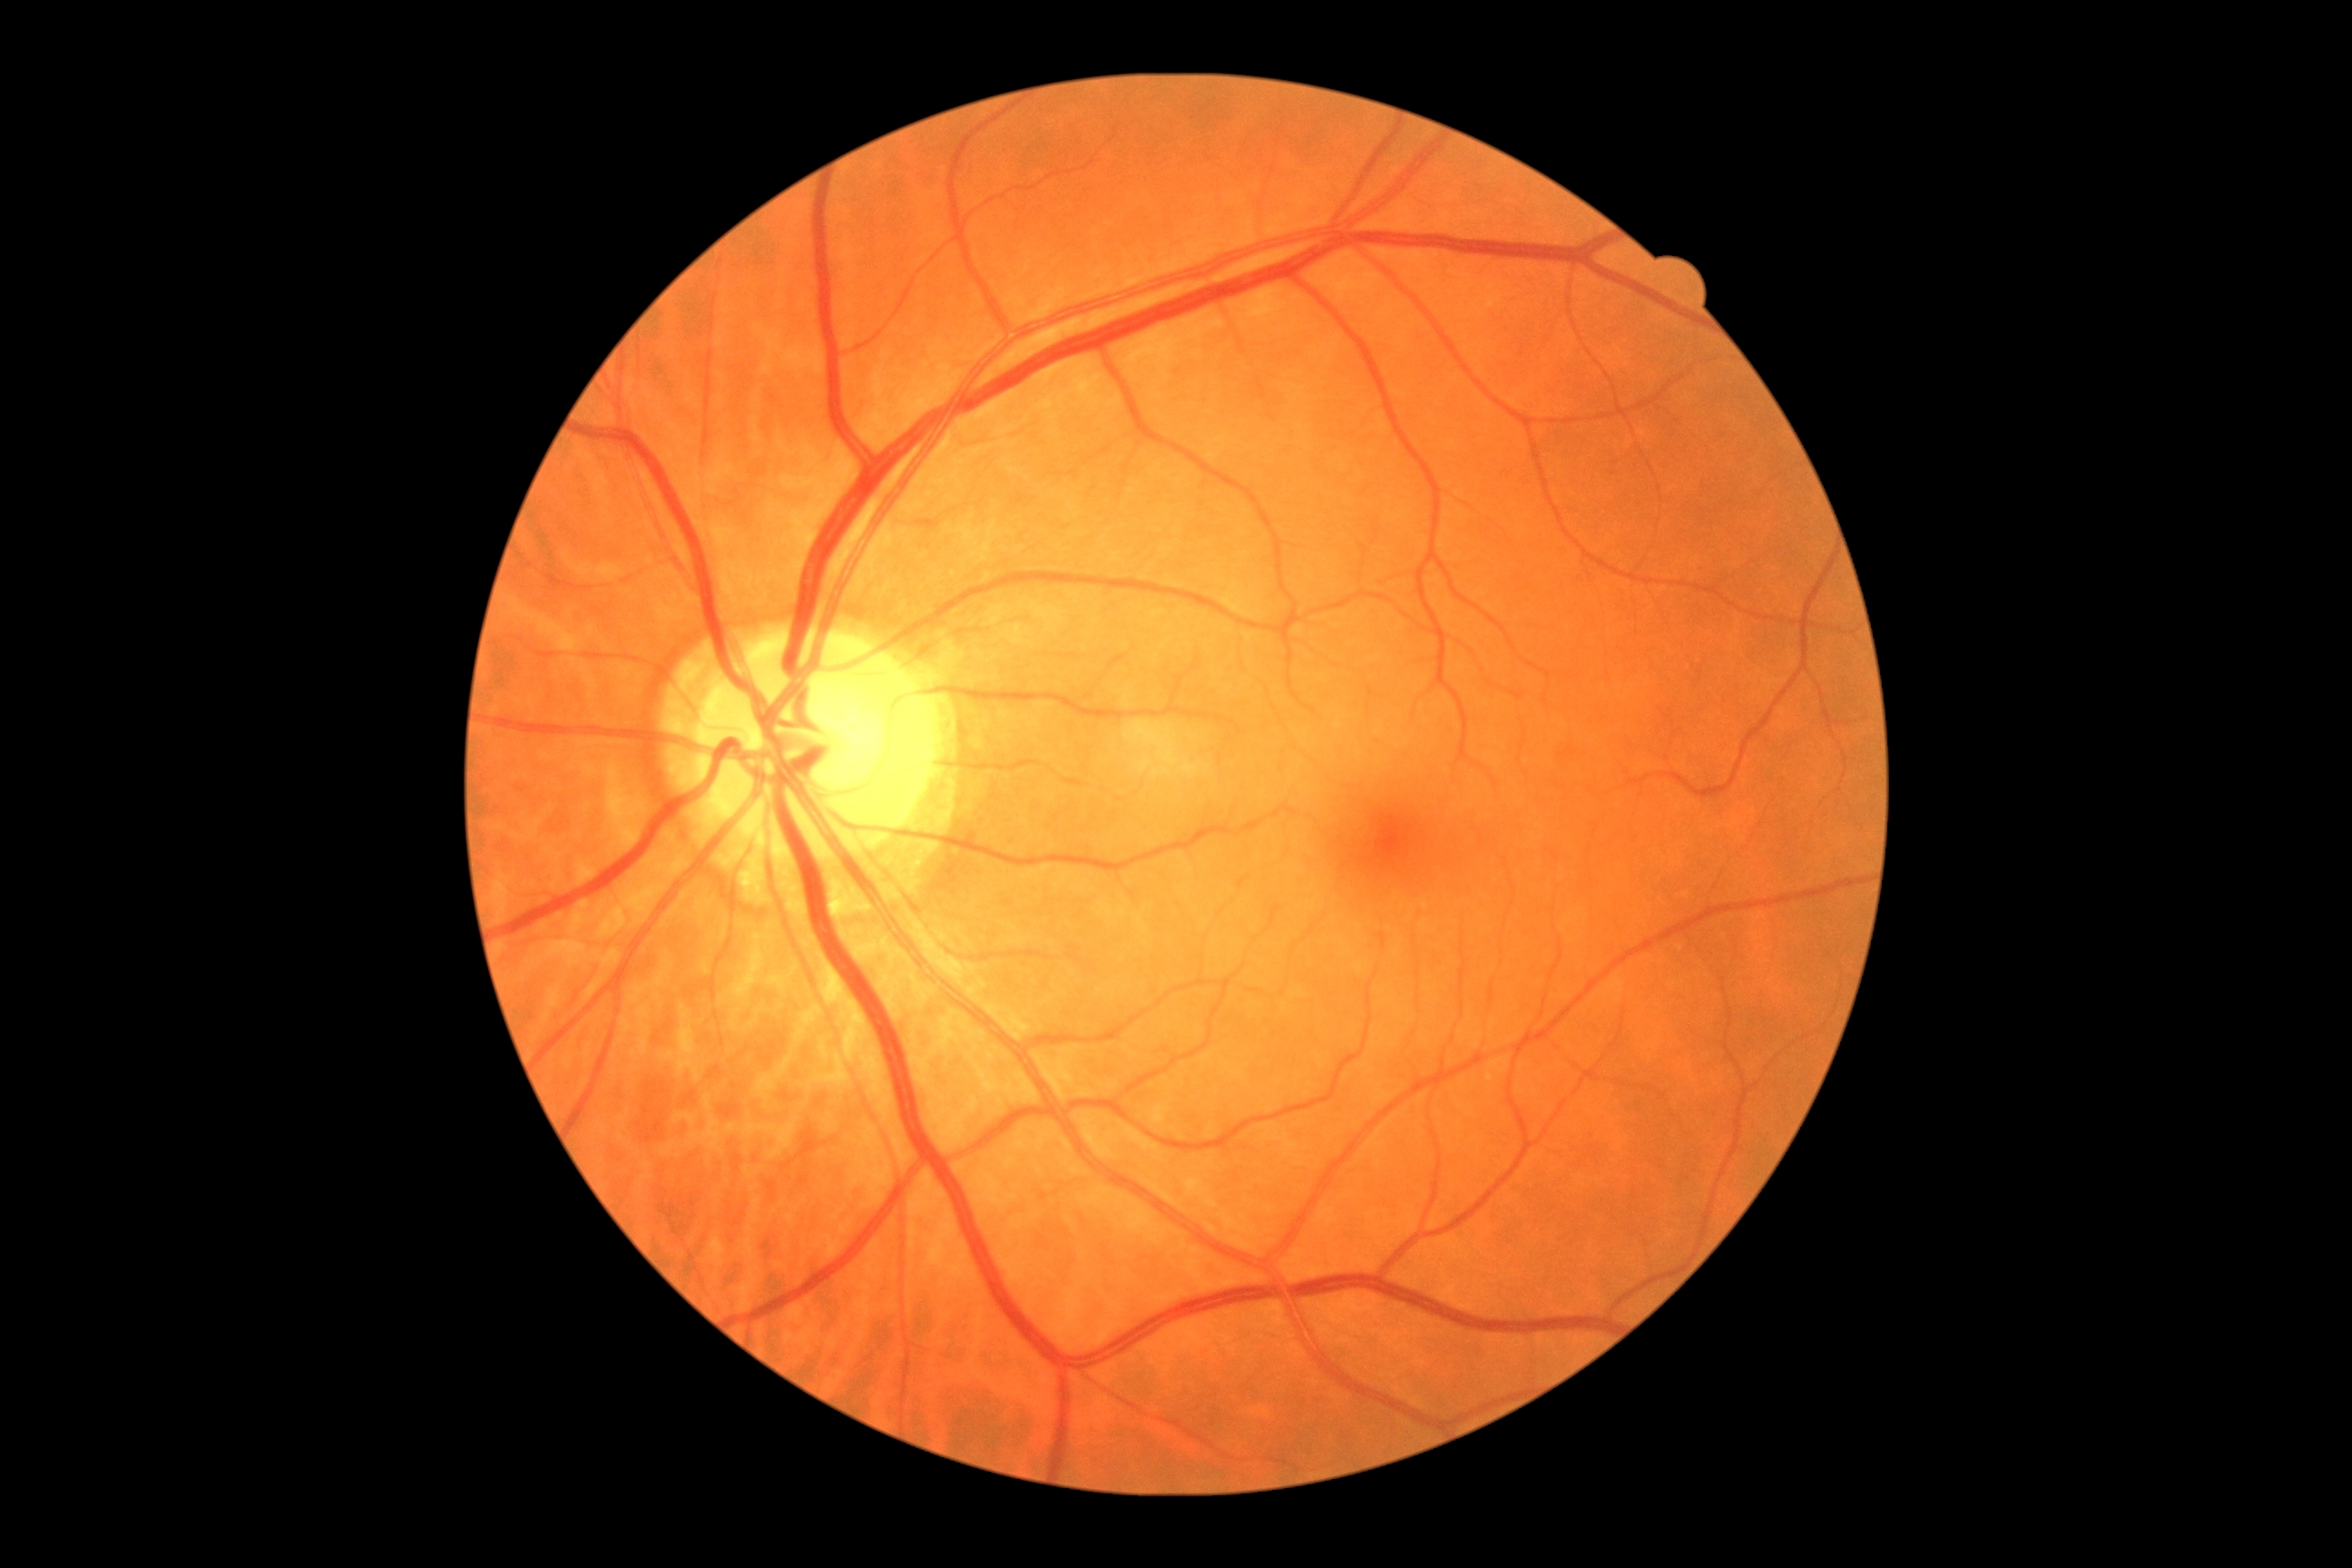

Diabetic retinopathy (DR): grade 0 (no apparent retinopathy).